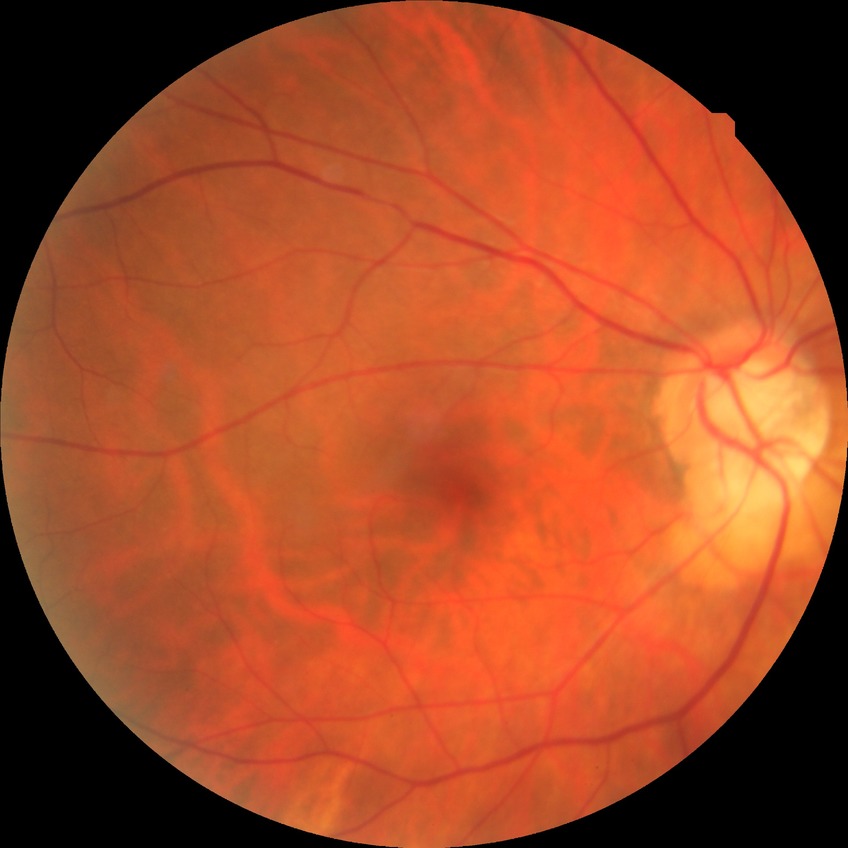 diabetic retinopathy (DR)=NDR (no diabetic retinopathy).